Disc-centered fundus crop · 35° FOV before cropping:
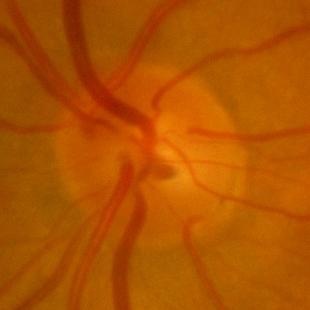
Q: Glaucoma assessment?
A: No — no signs of glaucoma.